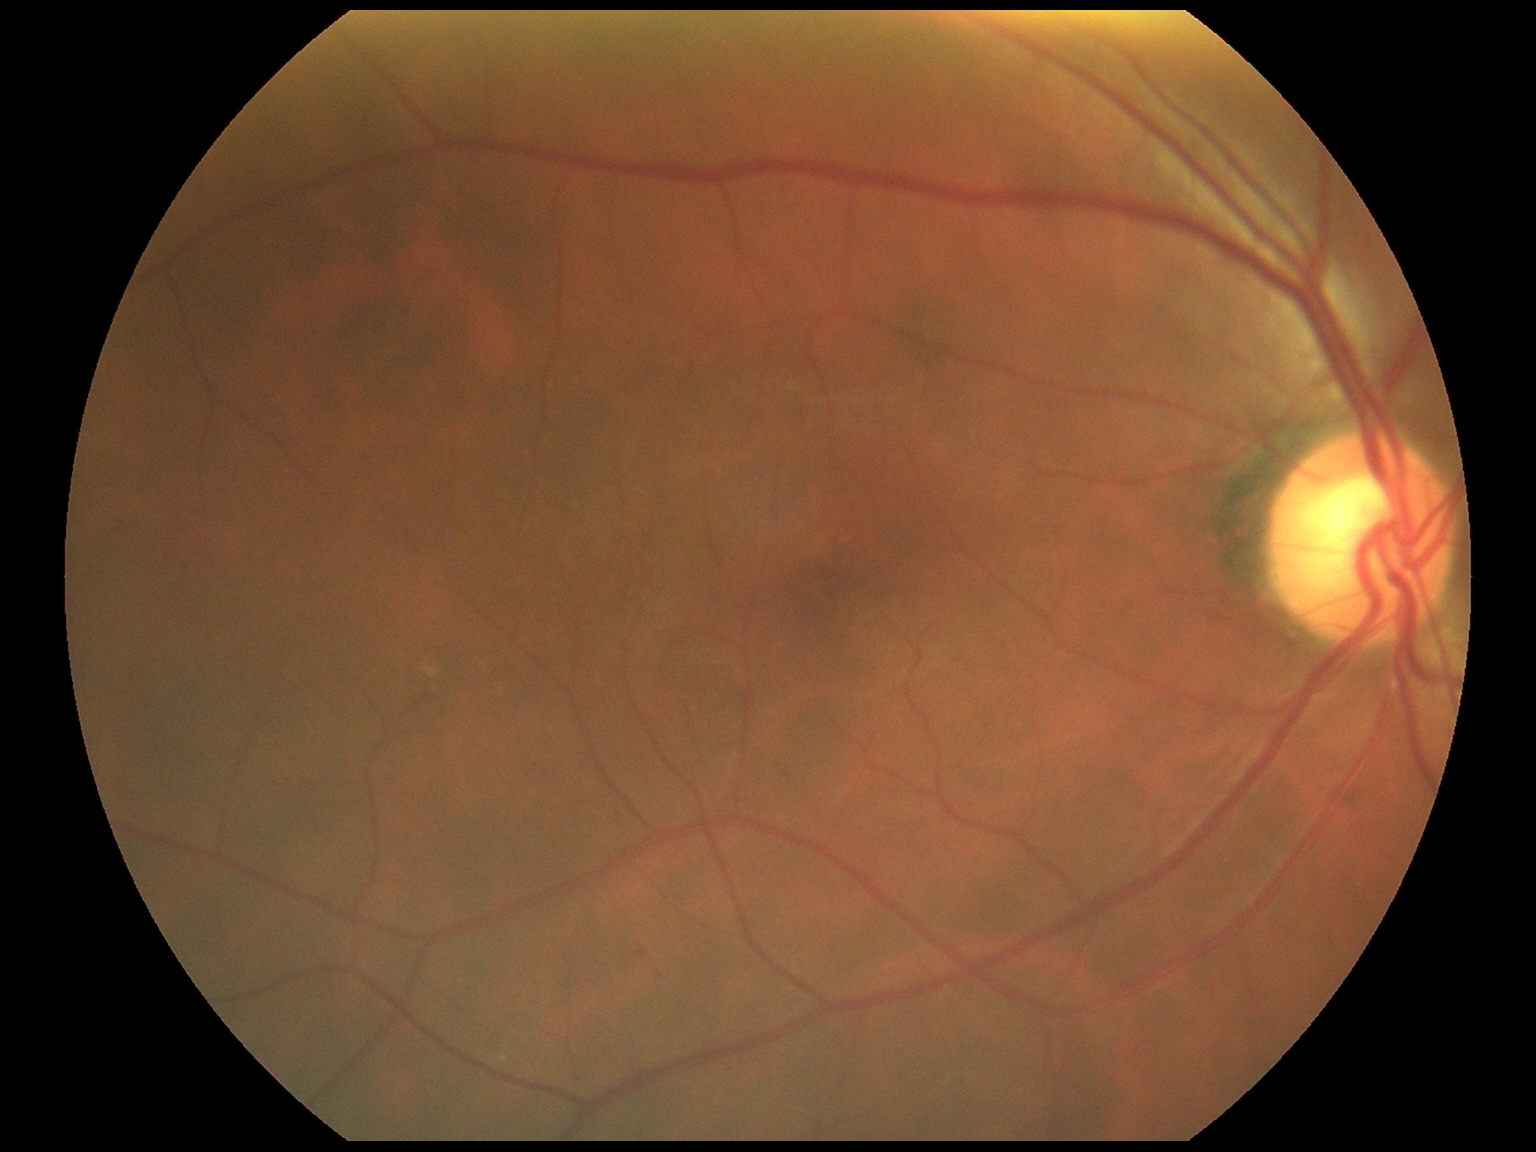 Diabetic retinopathy severity: grade 1.